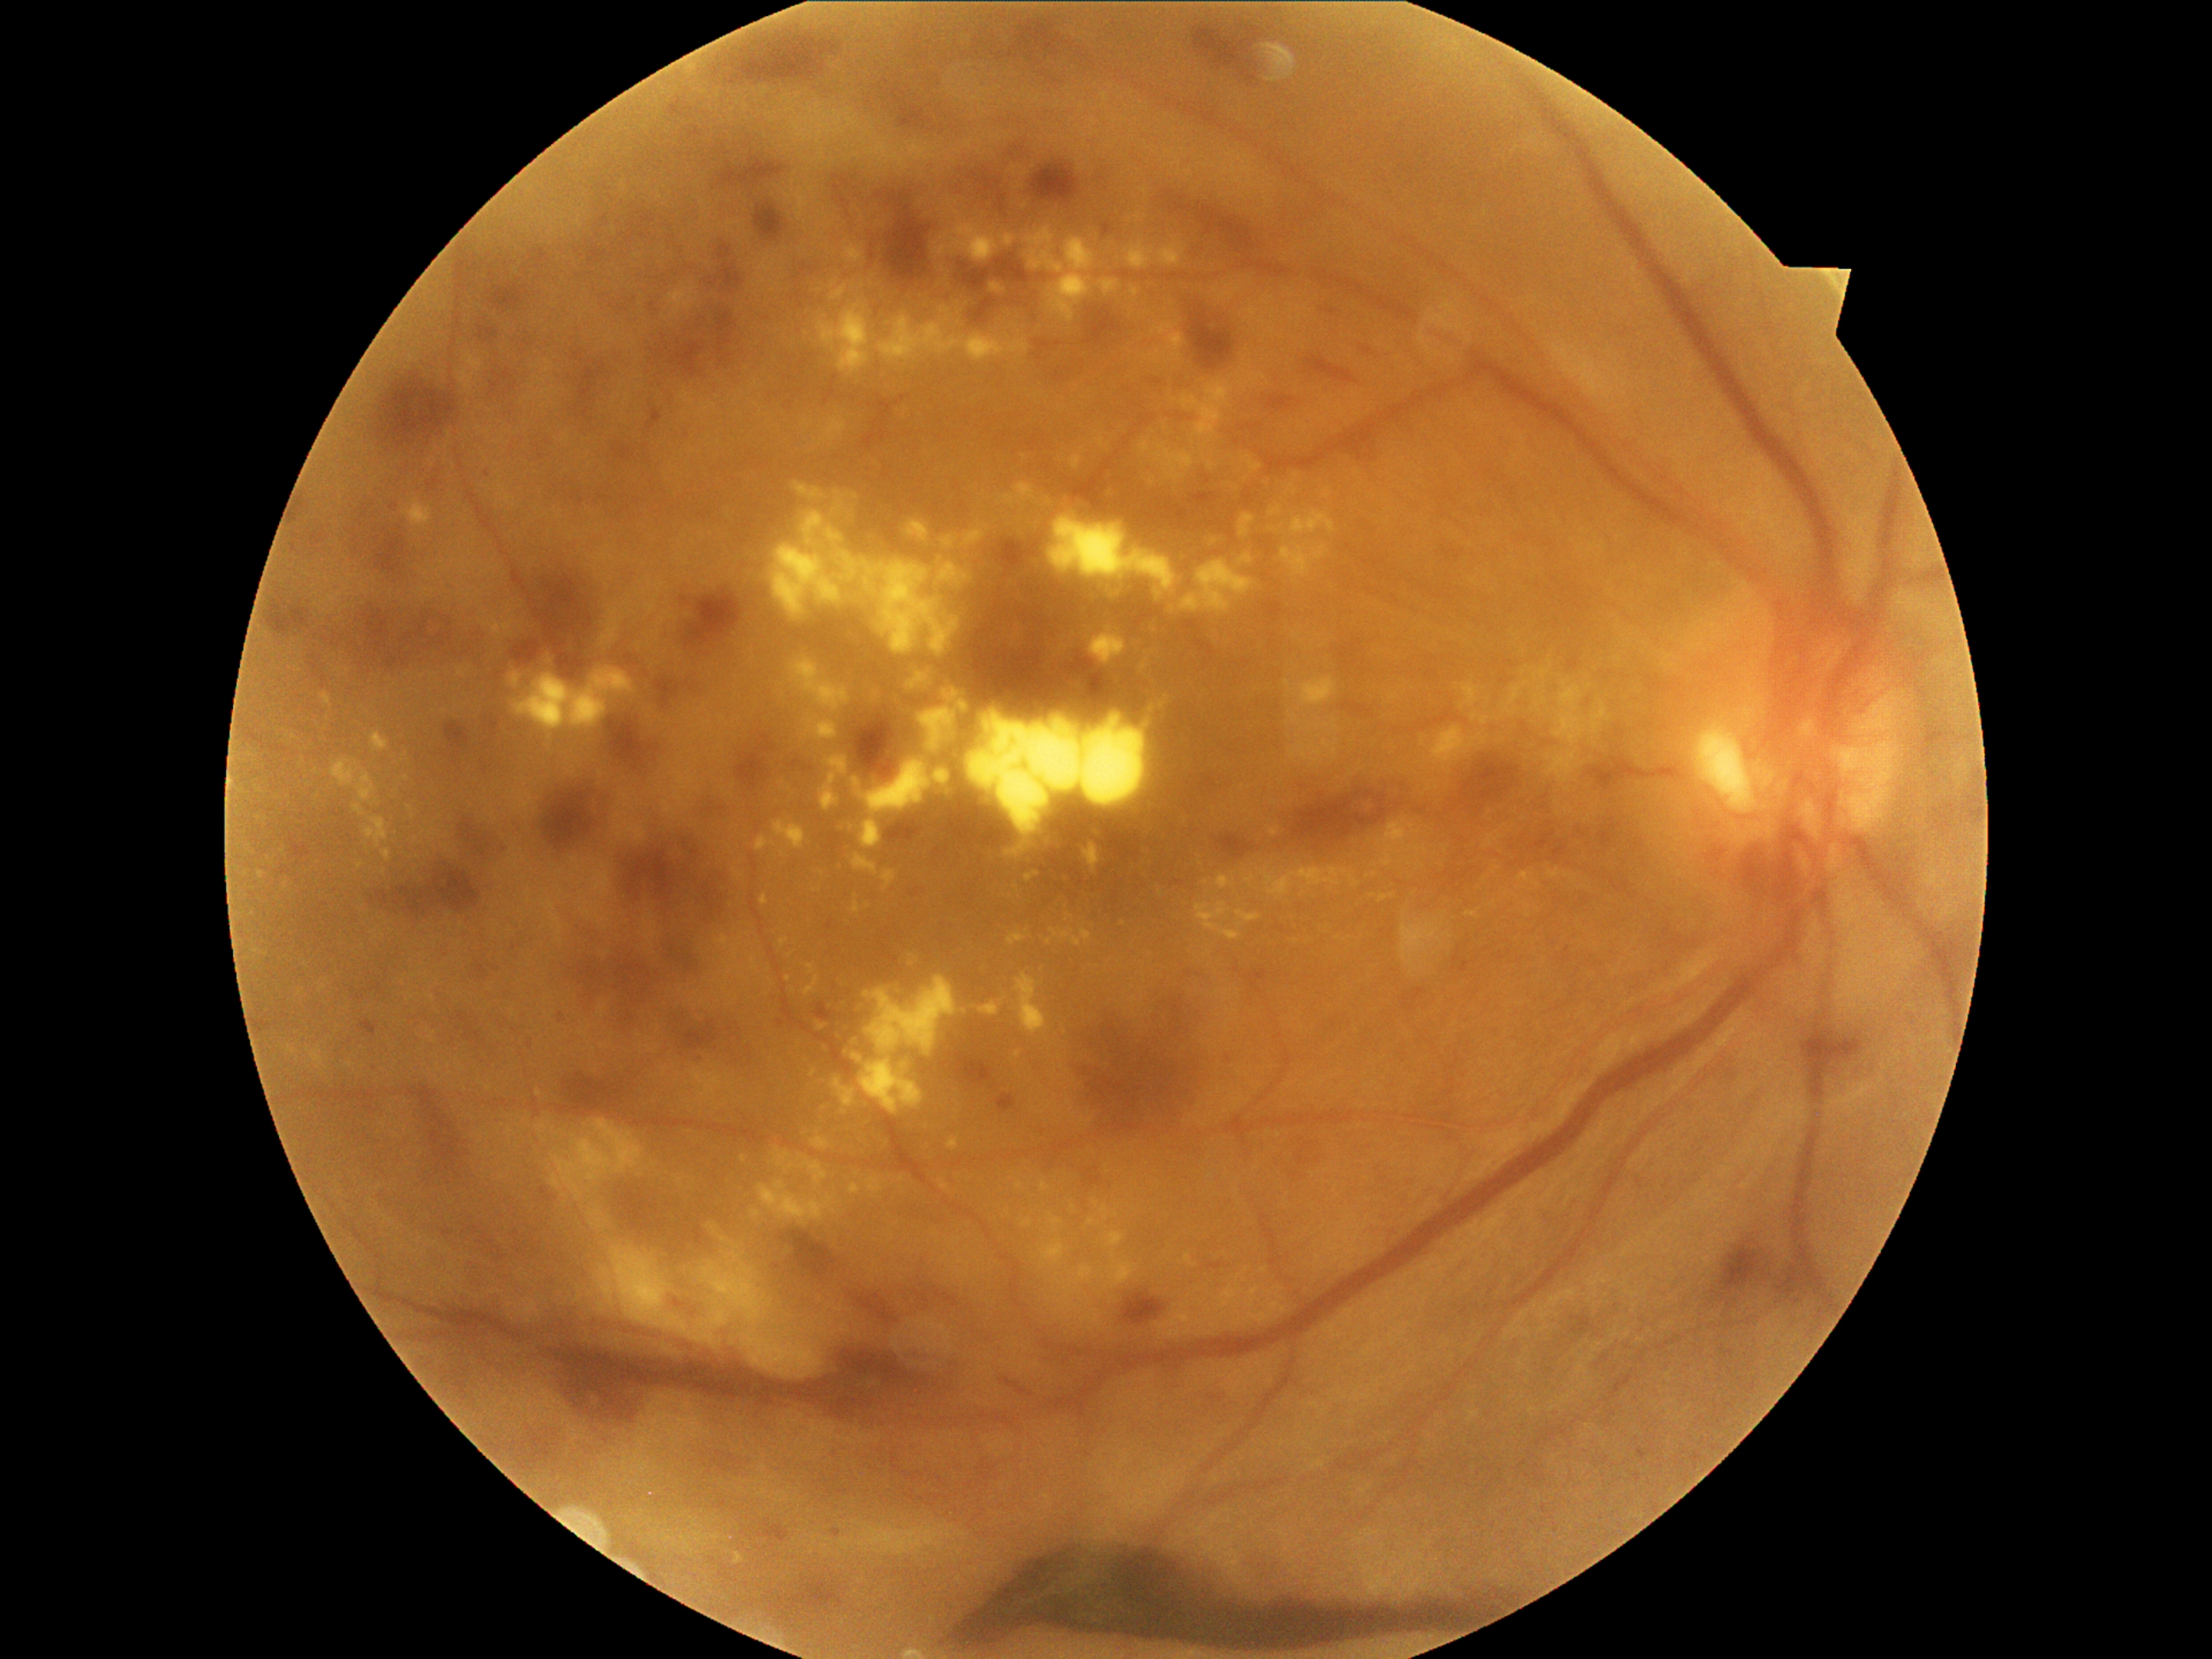 Diabetic retinopathy (DR): 4
Selected lesions:
hemorrhages (HEs) (more not shown): (x1=646, y1=998, x2=745, y2=1052), (x1=1122, y1=1293, x2=1167, y2=1325), (x1=1086, y1=310, x2=1124, y2=346), (x1=885, y1=190, x2=933, y2=282), (x1=1161, y1=192, x2=1194, y2=214), (x1=607, y1=718, x2=653, y2=772), (x1=504, y1=569, x2=600, y2=682), (x1=1602, y1=825, x2=1617, y2=847), (x1=455, y1=818, x2=516, y2=873), (x1=1056, y1=982, x2=1211, y2=1141), (x1=361, y1=520, x2=416, y2=571), (x1=950, y1=1534, x2=1516, y2=1656), (x1=996, y1=259, x2=1030, y2=284), (x1=639, y1=310, x2=748, y2=376), (x1=1511, y1=830, x2=1571, y2=870), (x1=1030, y1=161, x2=1080, y2=206), (x1=1711, y1=1242, x2=1774, y2=1301), (x1=849, y1=1295, x2=894, y2=1322)
hard exudates (EXs) (more not shown): (x1=774, y1=1150, x2=798, y2=1173), (x1=755, y1=835, x2=776, y2=853), (x1=759, y1=1180, x2=837, y2=1225), (x1=1481, y1=718, x2=1489, y2=725), (x1=765, y1=475, x2=972, y2=692), (x1=364, y1=817, x2=392, y2=849), (x1=1085, y1=1317, x2=1098, y2=1324), (x1=1139, y1=438, x2=1153, y2=455), (x1=1271, y1=829, x2=1279, y2=837), (x1=1286, y1=677, x2=1339, y2=707), (x1=933, y1=771, x2=952, y2=786), (x1=352, y1=805, x2=366, y2=817), (x1=381, y1=849, x2=392, y2=861)
Additional small EXs near (798,695), (741,875), (746,935), (1274,804), (1242,788), (1280,1289), (1589,687)
microaneurysms (MAs) (more not shown): (x1=1571, y1=1318, x2=1593, y2=1334), (x1=1018, y1=21, x2=1062, y2=62), (x1=300, y1=504, x2=308, y2=513), (x1=721, y1=265, x2=743, y2=294), (x1=682, y1=598, x2=690, y2=605), (x1=670, y1=107, x2=687, y2=117), (x1=313, y1=535, x2=325, y2=545), (x1=472, y1=963, x2=489, y2=981), (x1=311, y1=658, x2=320, y2=670), (x1=491, y1=370, x2=515, y2=390), (x1=614, y1=448, x2=634, y2=460), (x1=1264, y1=602, x2=1283, y2=624), (x1=975, y1=298, x2=998, y2=325), (x1=1218, y1=834, x2=1250, y2=859)
Additional small MAs near (1159,382), (1057,345), (515,948)
soft exudates (SEs) (more not shown): (x1=549, y1=1121, x2=646, y2=1201), (x1=842, y1=1325, x2=851, y2=1334), (x1=721, y1=1237, x2=726, y2=1245), (x1=707, y1=1223, x2=716, y2=1231), (x1=730, y1=1337, x2=736, y2=1346), (x1=595, y1=1245, x2=839, y2=1378), (x1=588, y1=1211, x2=607, y2=1228), (x1=535, y1=1122, x2=549, y2=1136)
Additional small SEs near (591,1295), (589,1189), (545,1141), (792,1317), (550,1168), (514,1133), (728,1257), (735,1247), (558,1135)